Acquired with a NIDEK AFC-230, nonmydriatic, image size 848x848: 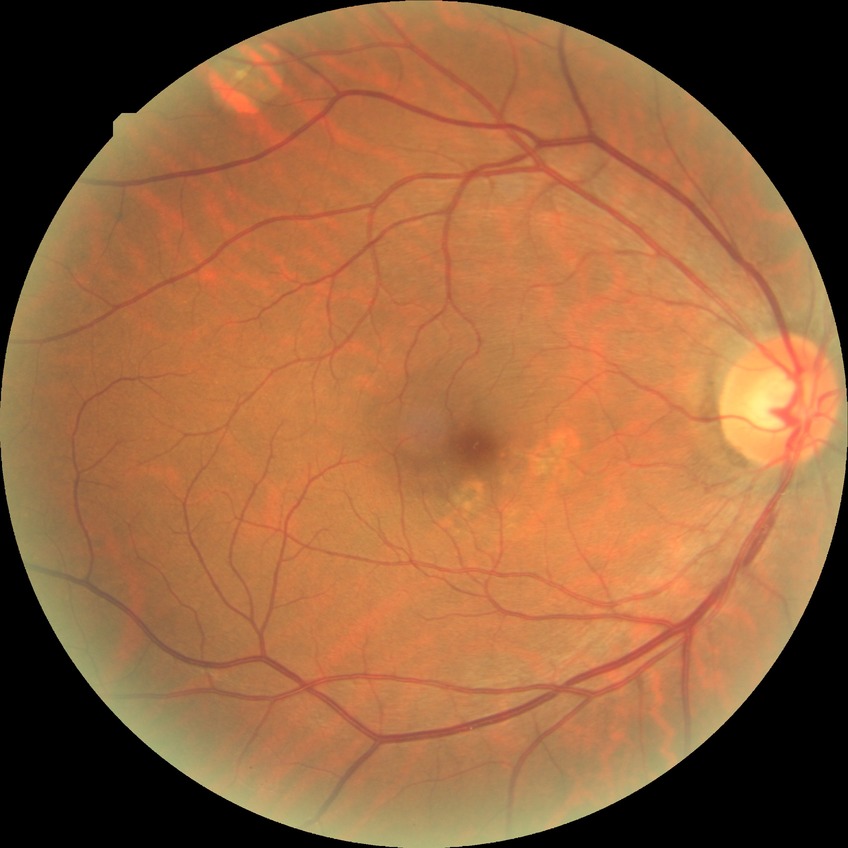 Diabetic retinopathy (DR) is no diabetic retinopathy (NDR).